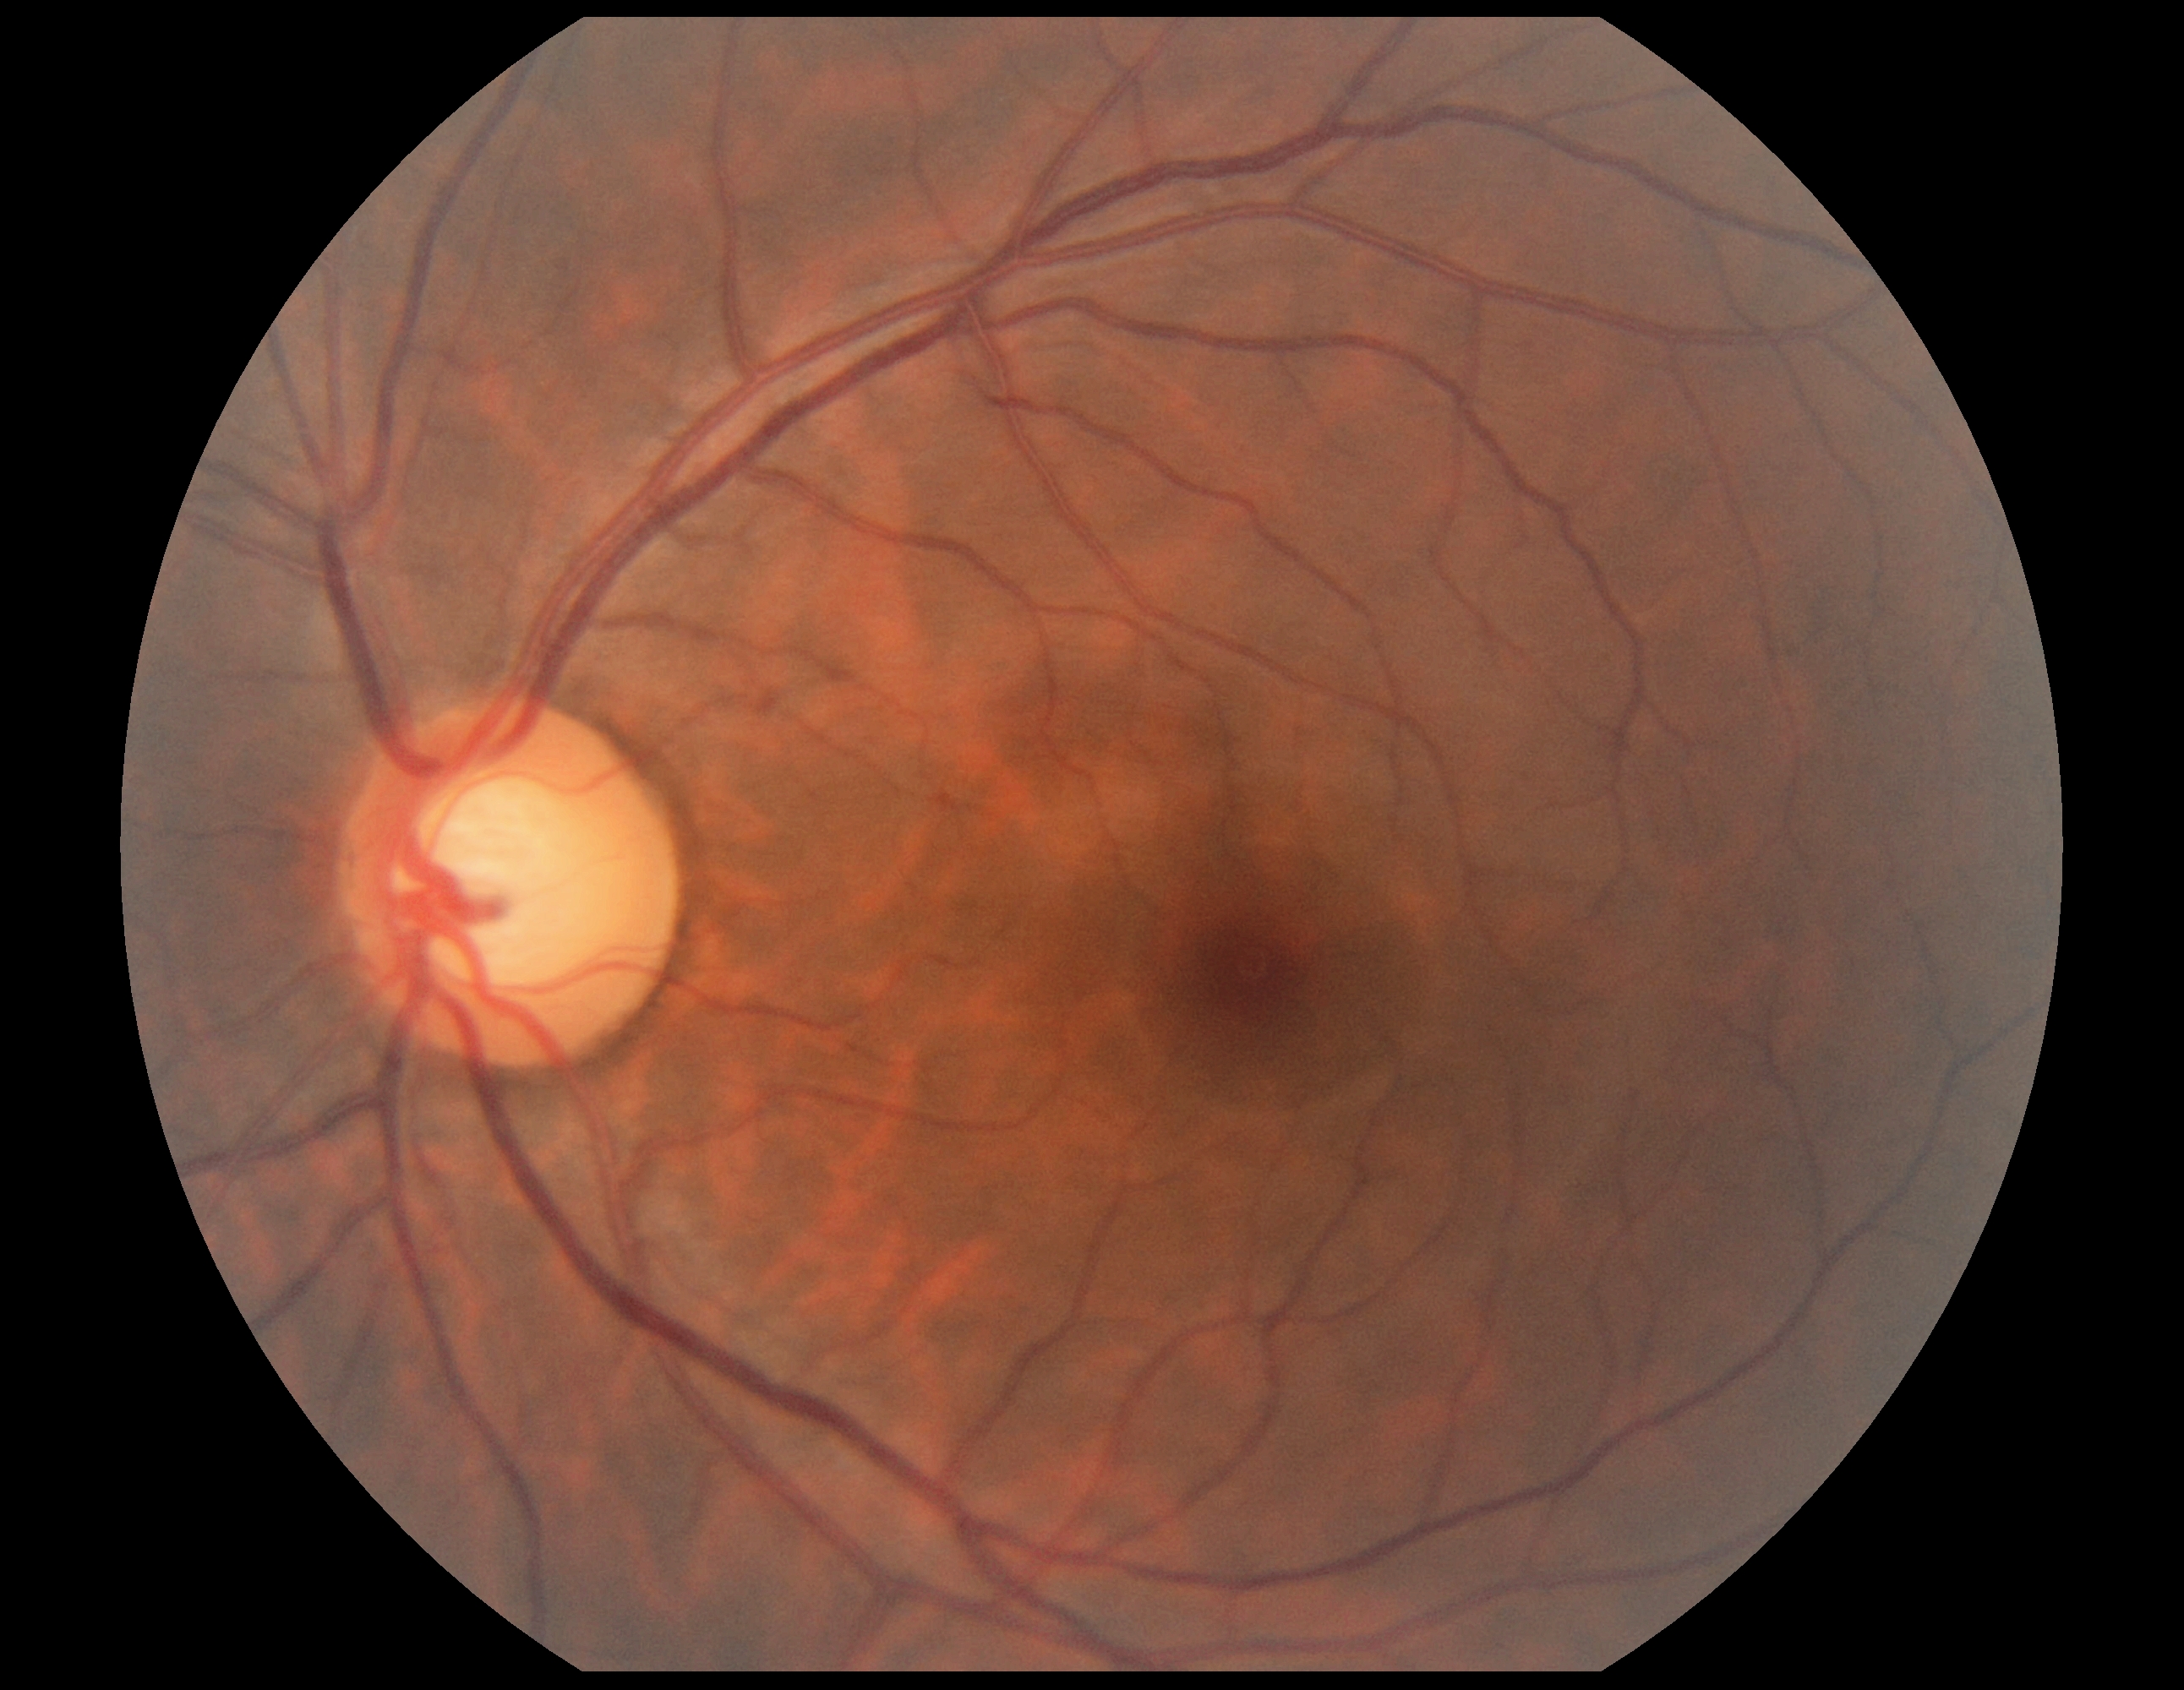
DR: 0/4 — no visible signs of diabetic retinopathy. No diabetic retinal disease findings.